Pediatric wide-field fundus photograph. Captured with the Clarity RetCam 3 (130° field of view).
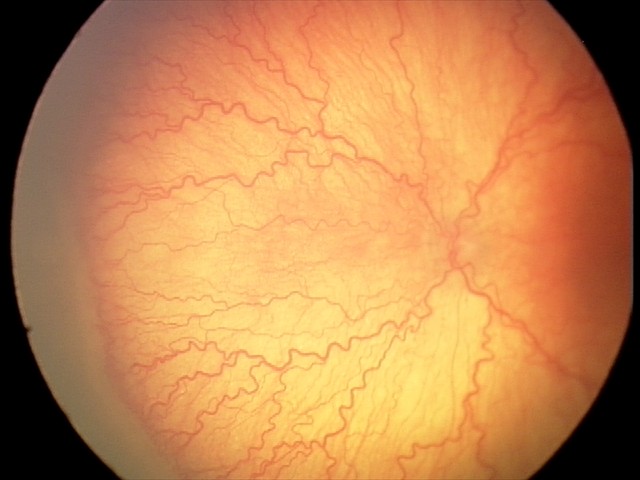
Screening series with A-ROP (aggressive ROP).
Plus disease was diagnosed.